848x848 · color fundus image · graded on the modified Davis scale · nonmydriatic: 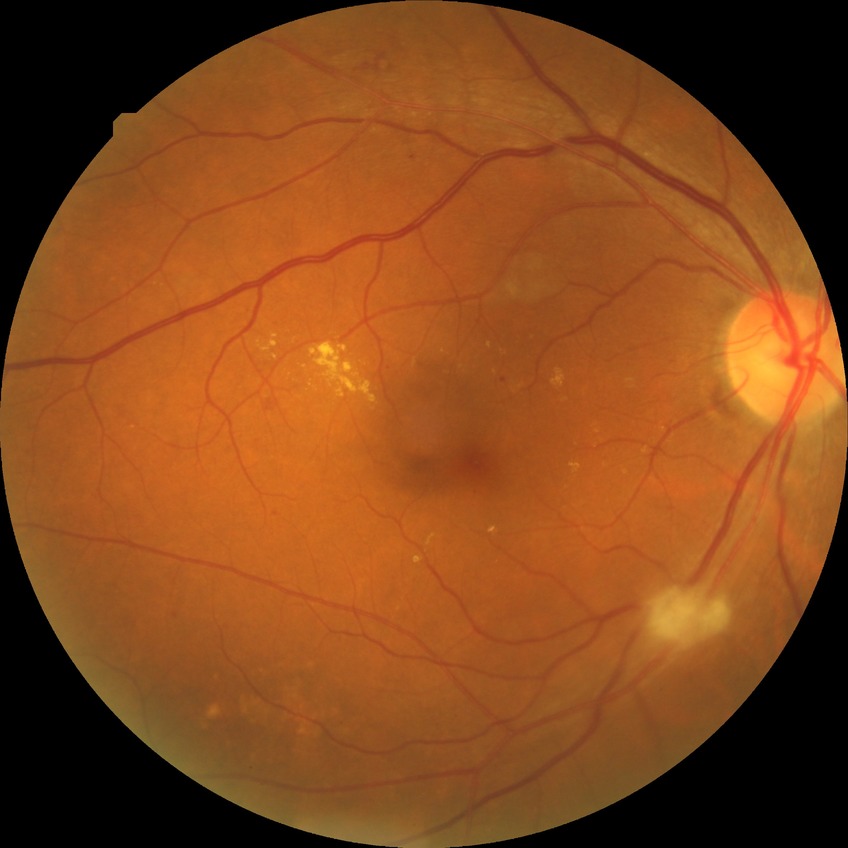

Findings:
- DR class: non-proliferative diabetic retinopathy
- diabetic retinopathy (DR): pre-proliferative diabetic retinopathy (PPDR)